Color fundus image; 2352 x 1568 pixels:
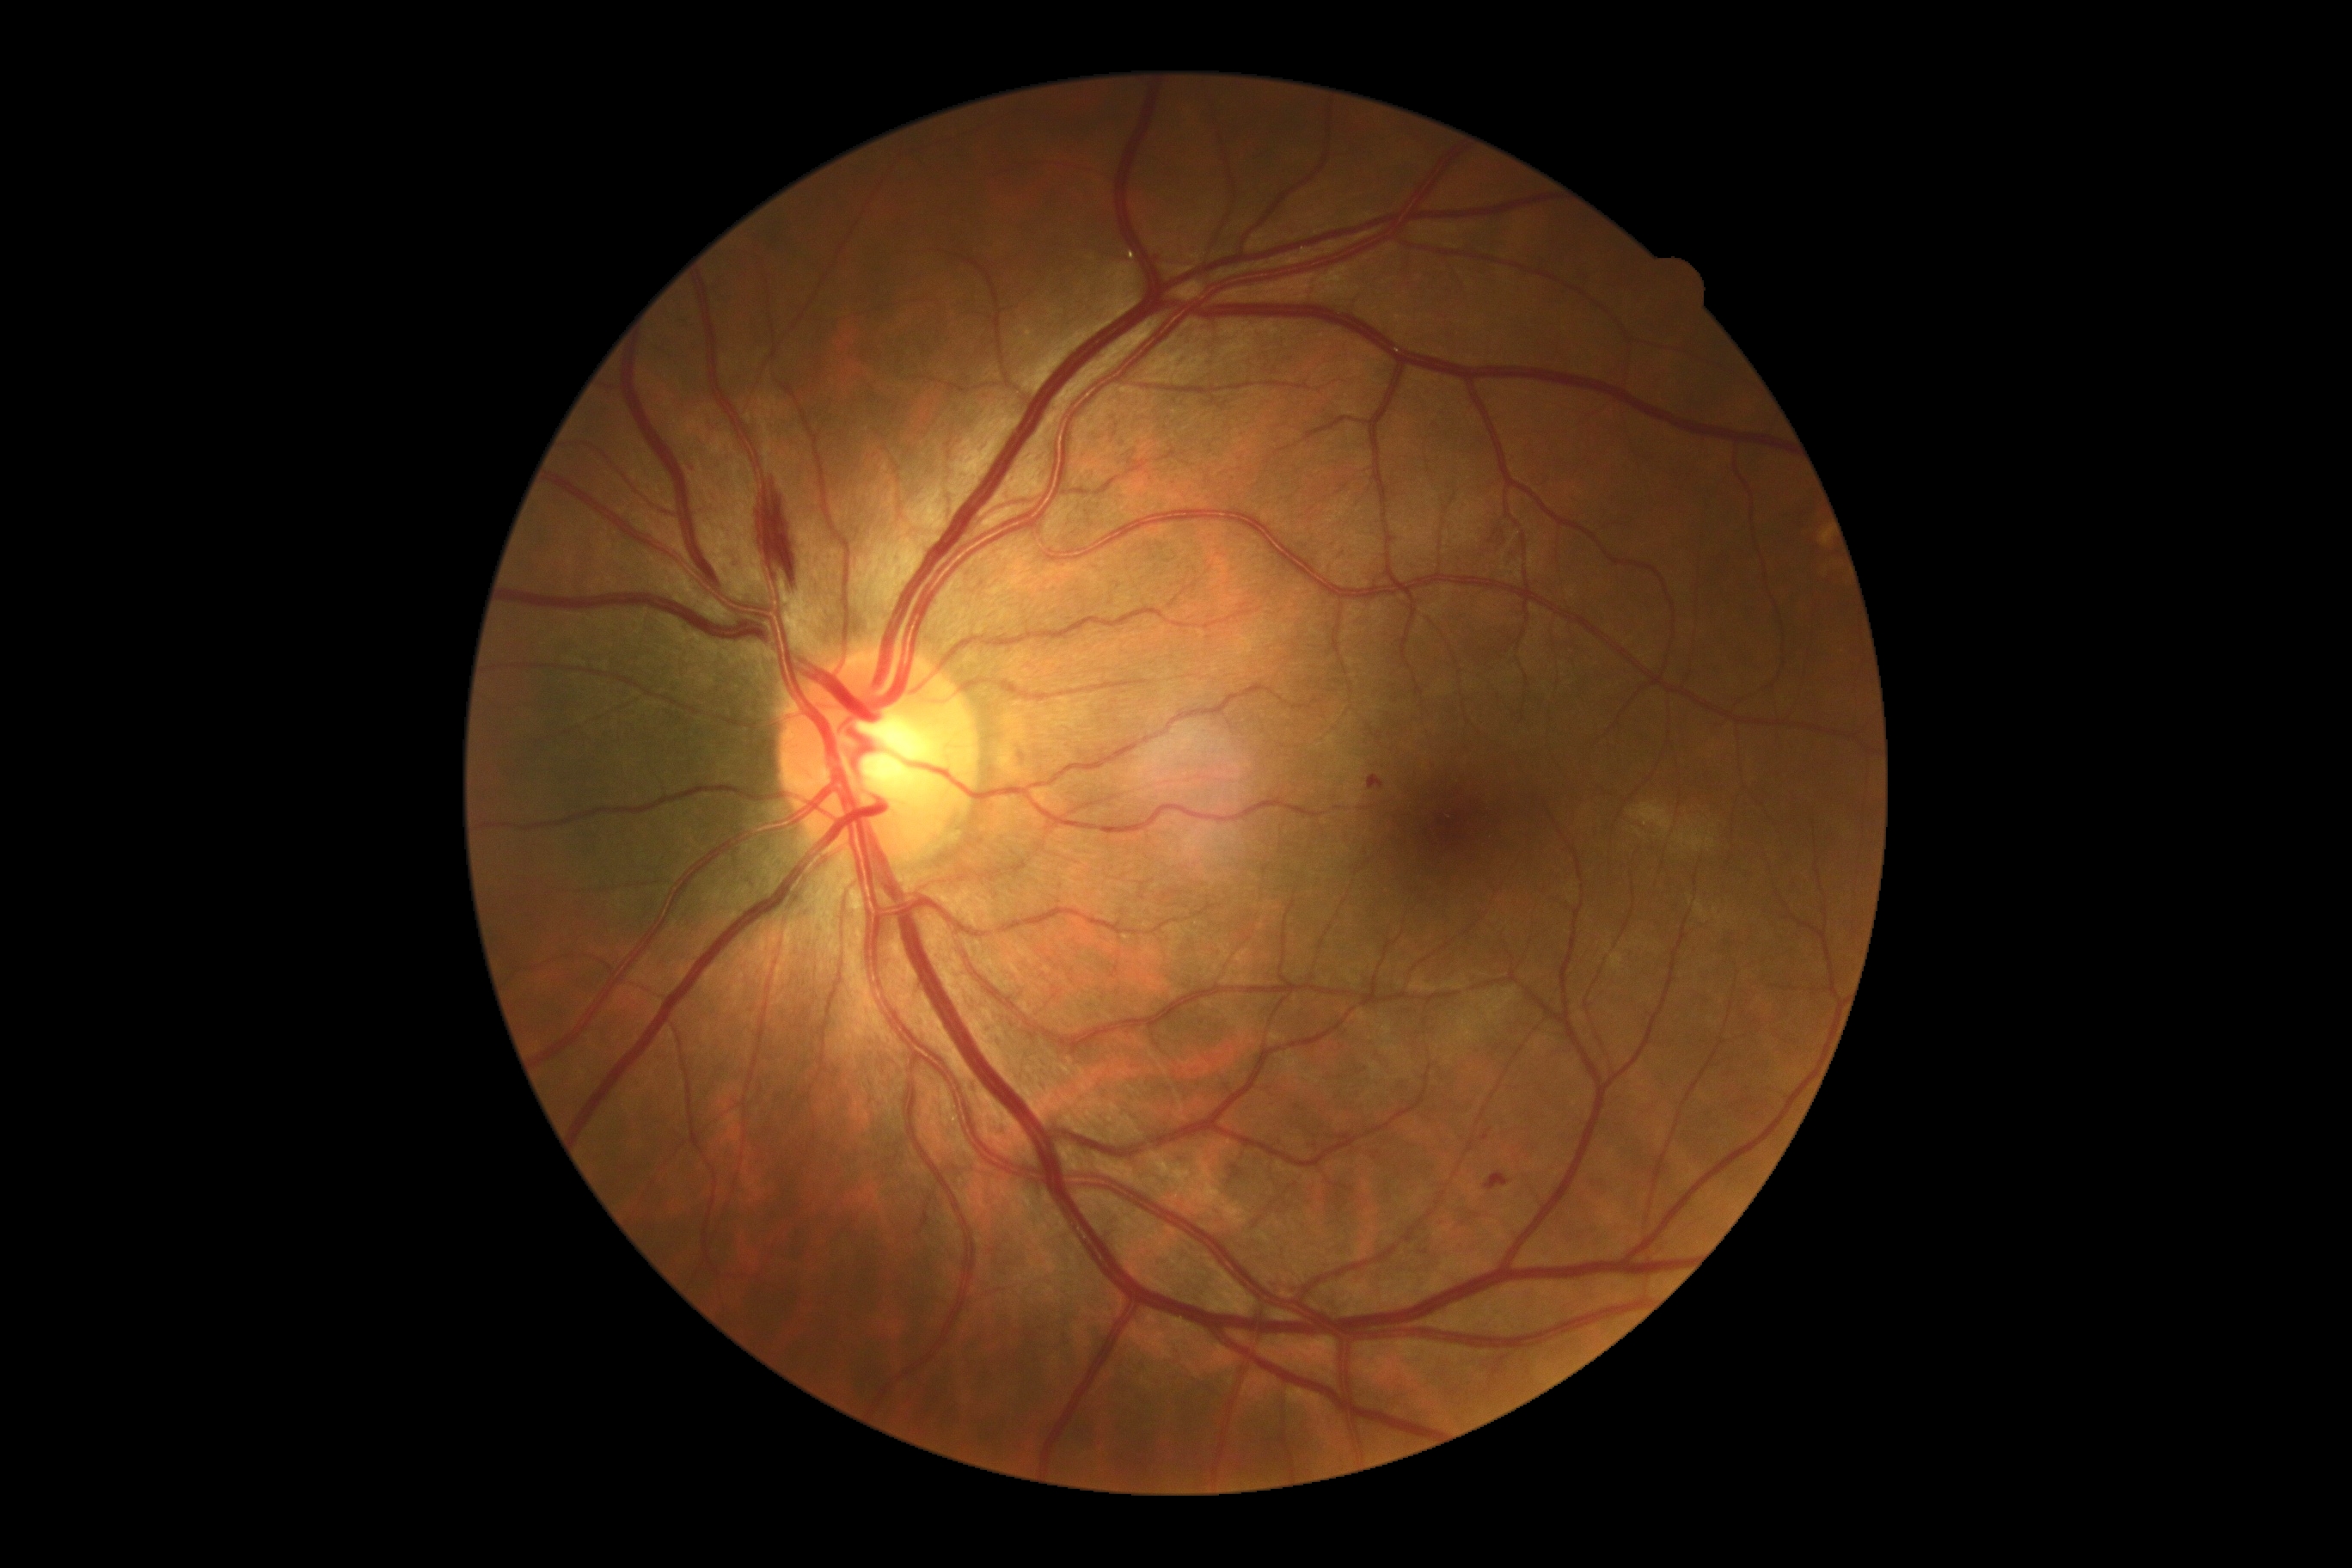
DR: moderate NPDR (grade 2).